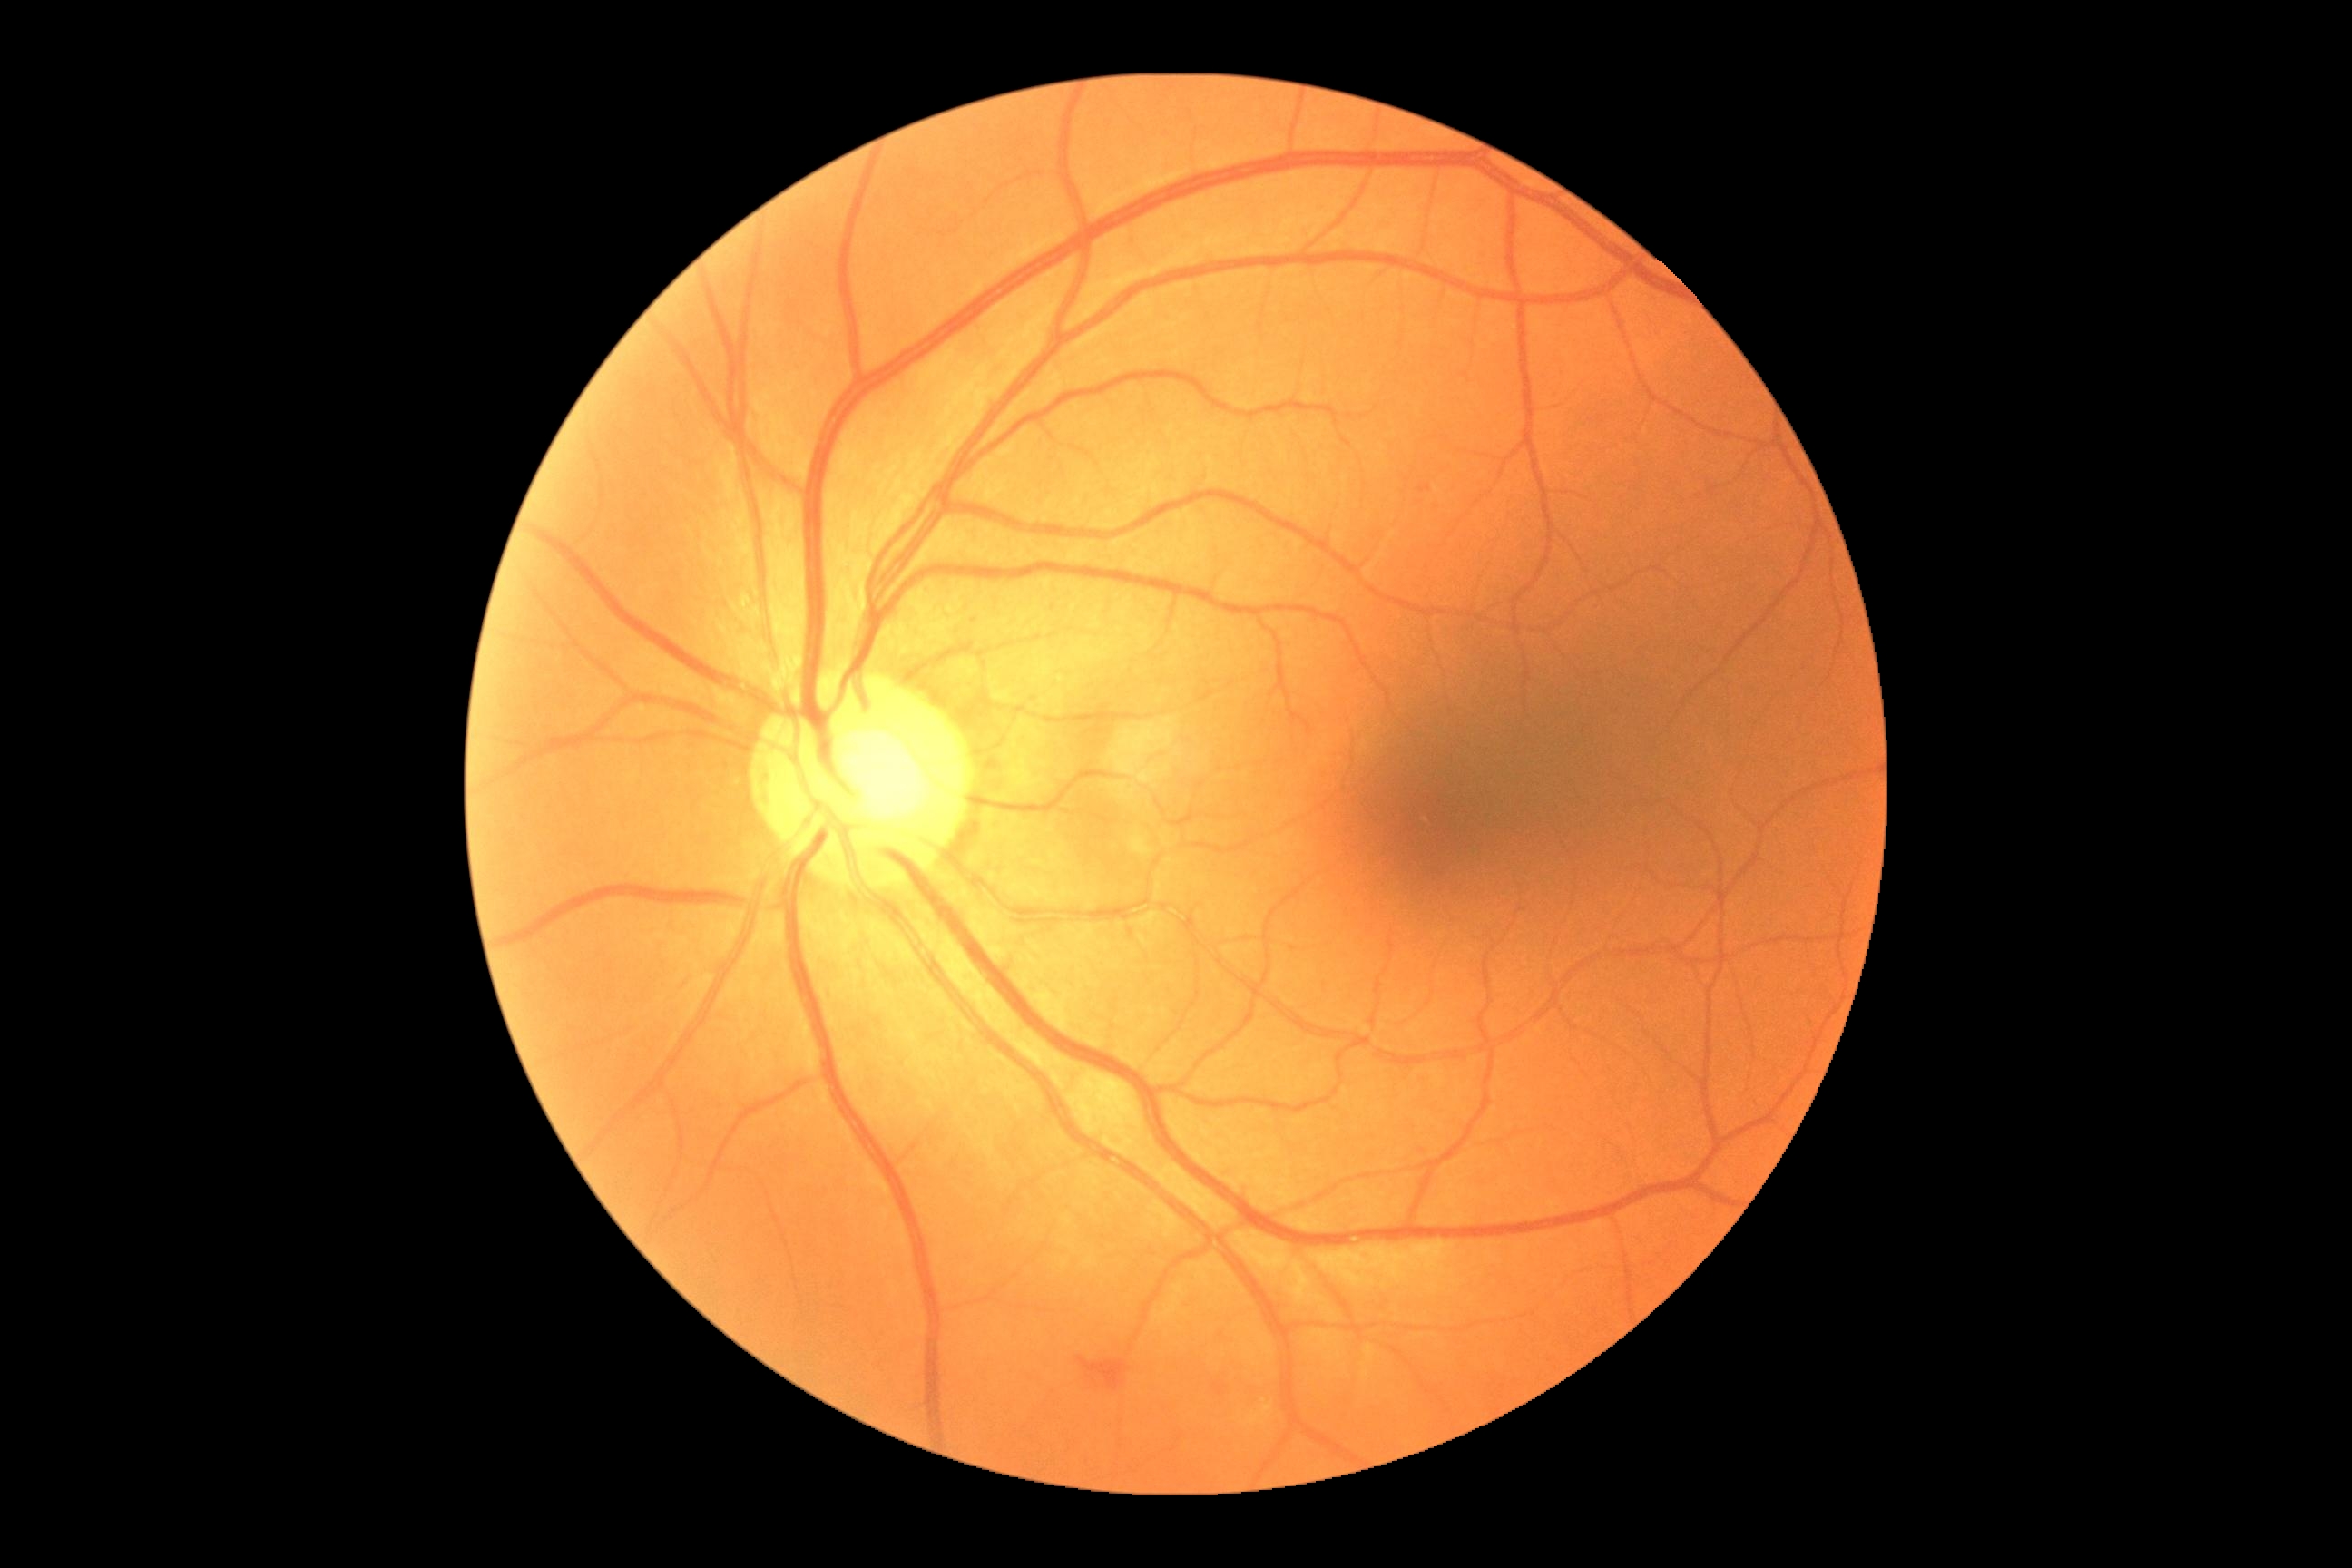

DR is moderate non-proliferative diabetic retinopathy (grade 2) — more than just microaneurysms but less than severe NPDR.